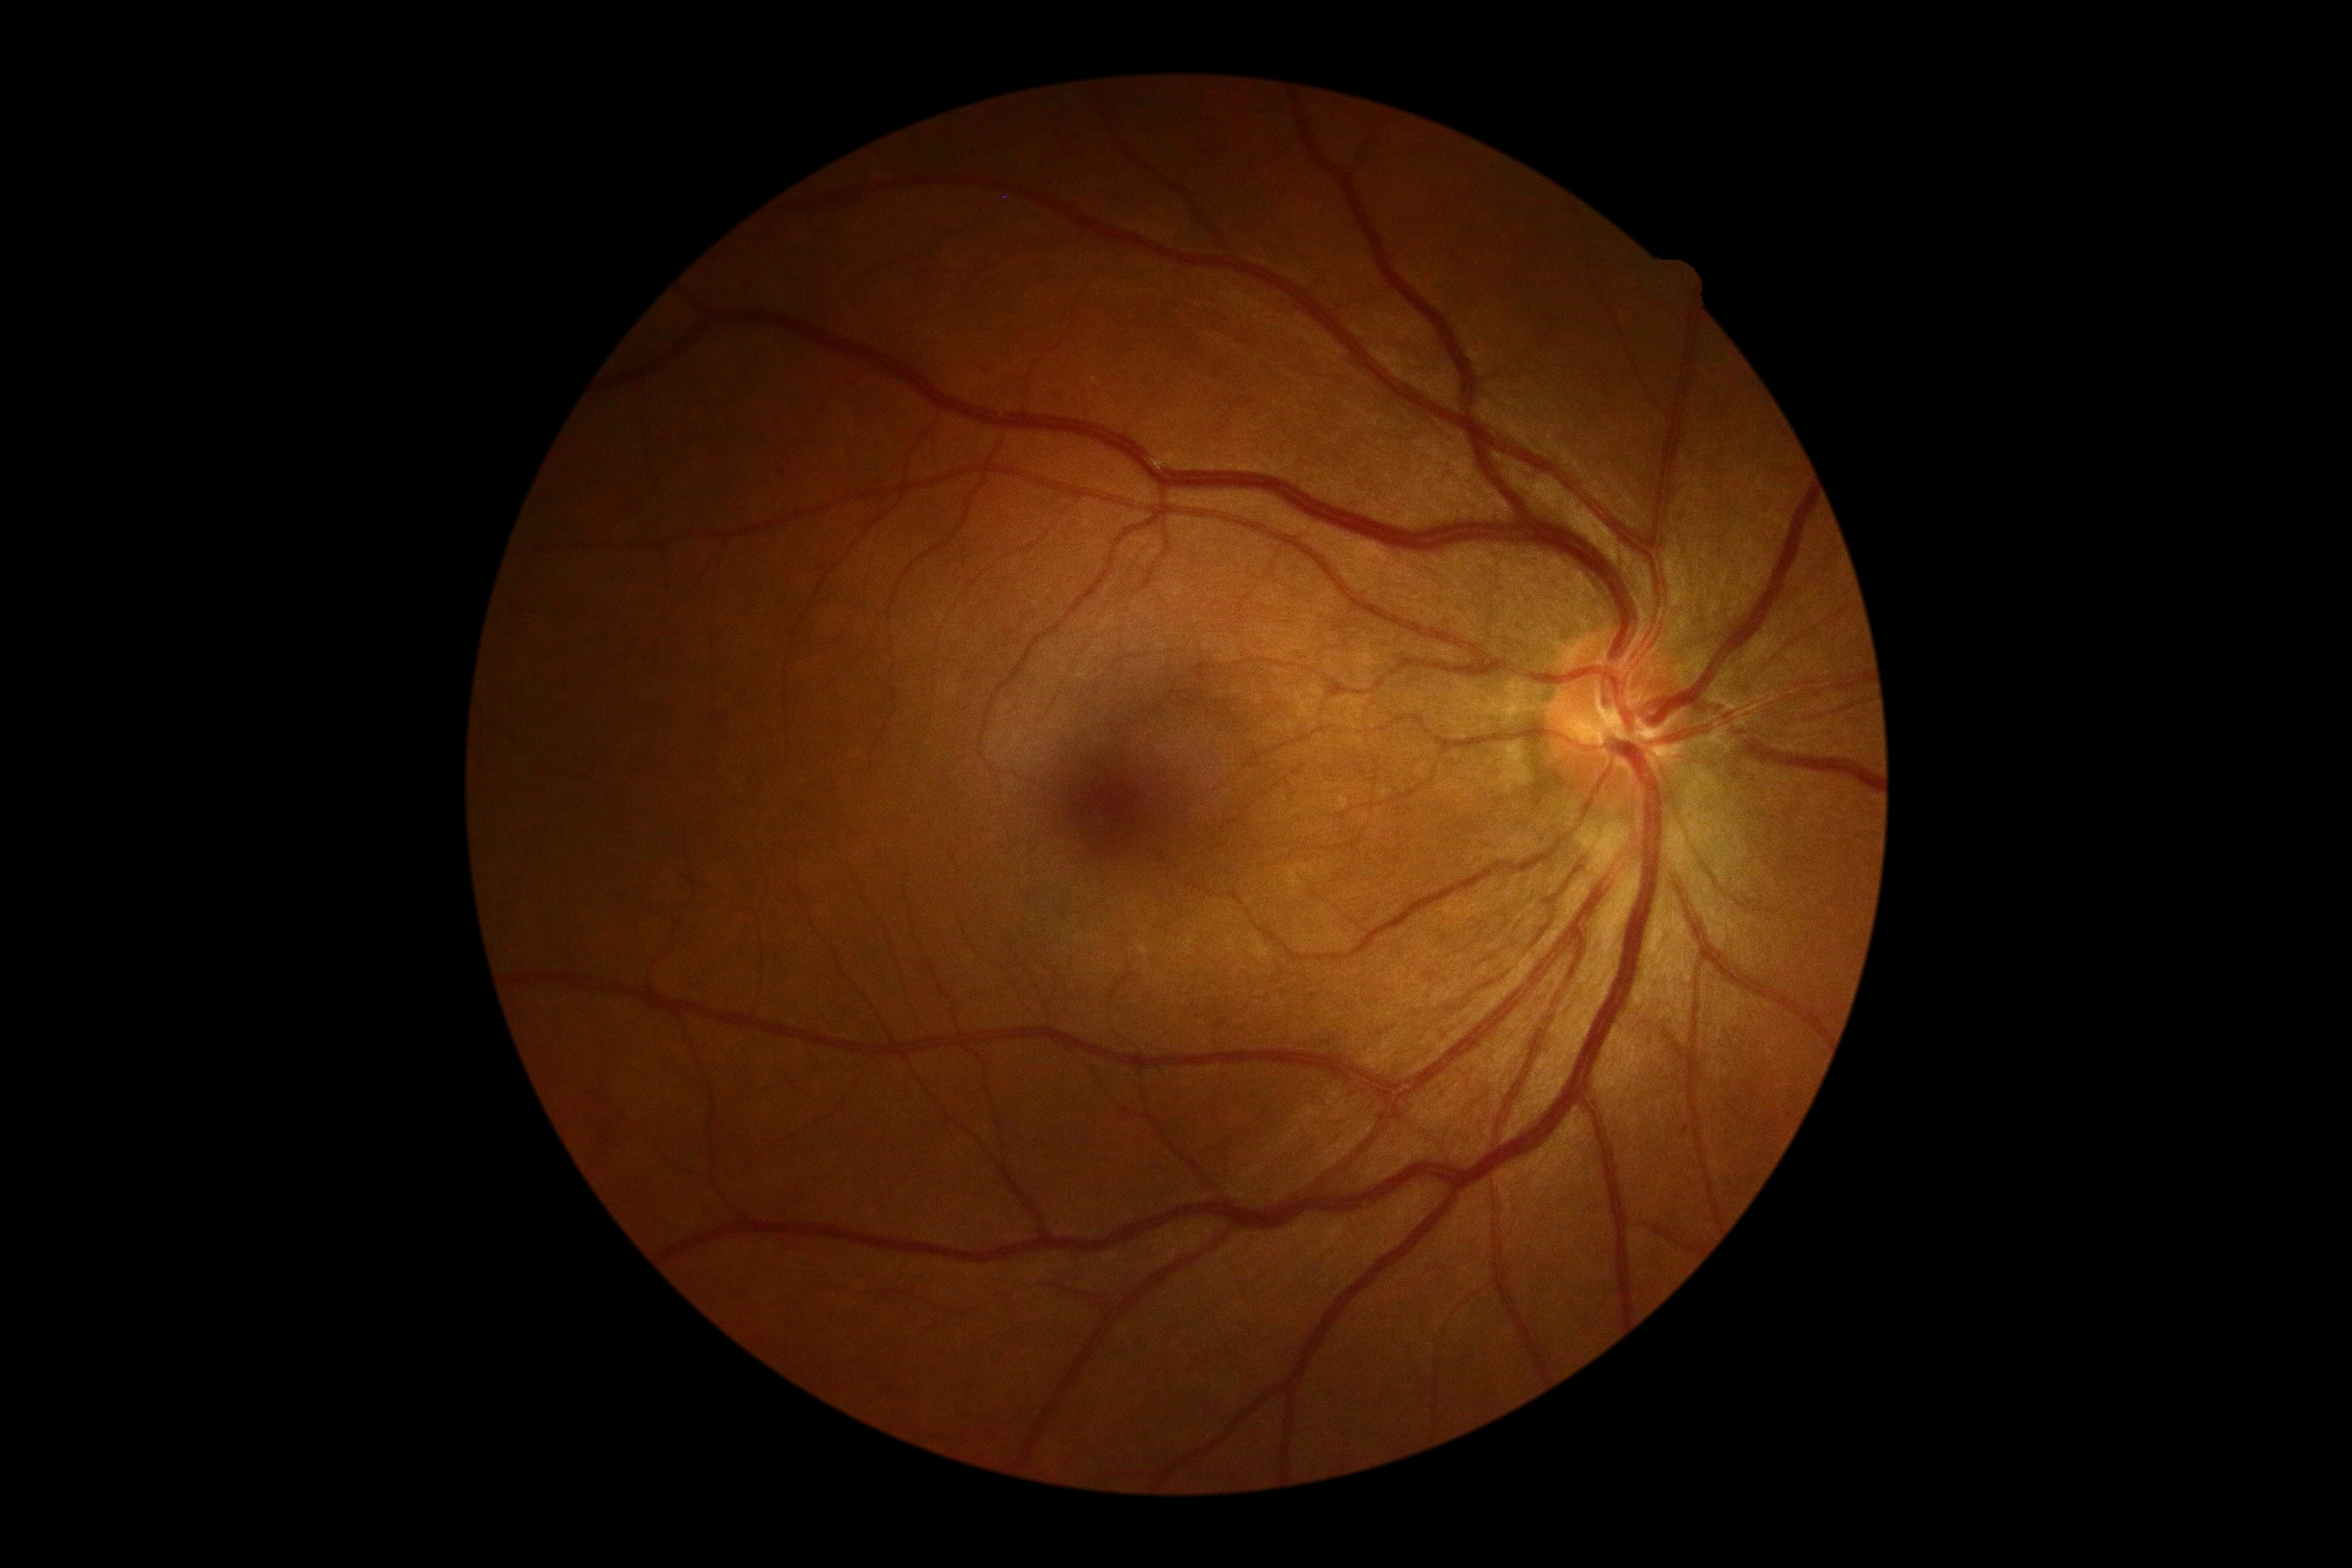 {
  "dr_impression": "no signs of DR",
  "dr_grade": "0 — no visible signs of diabetic retinopathy"
}